Wide-field contact fundus photograph of an infant.
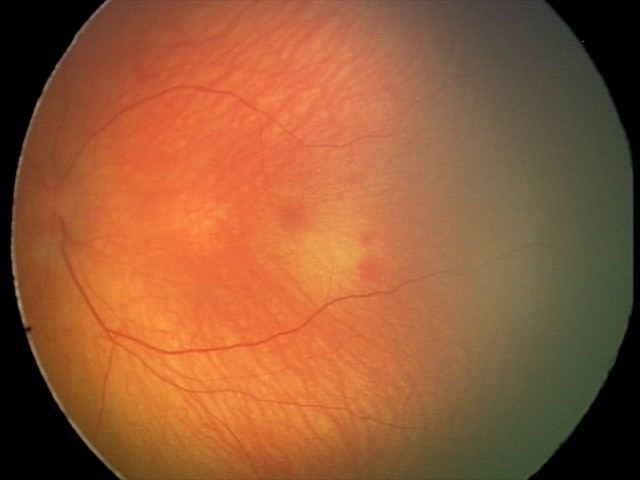 Screening diagnosis: normal fundus examination.